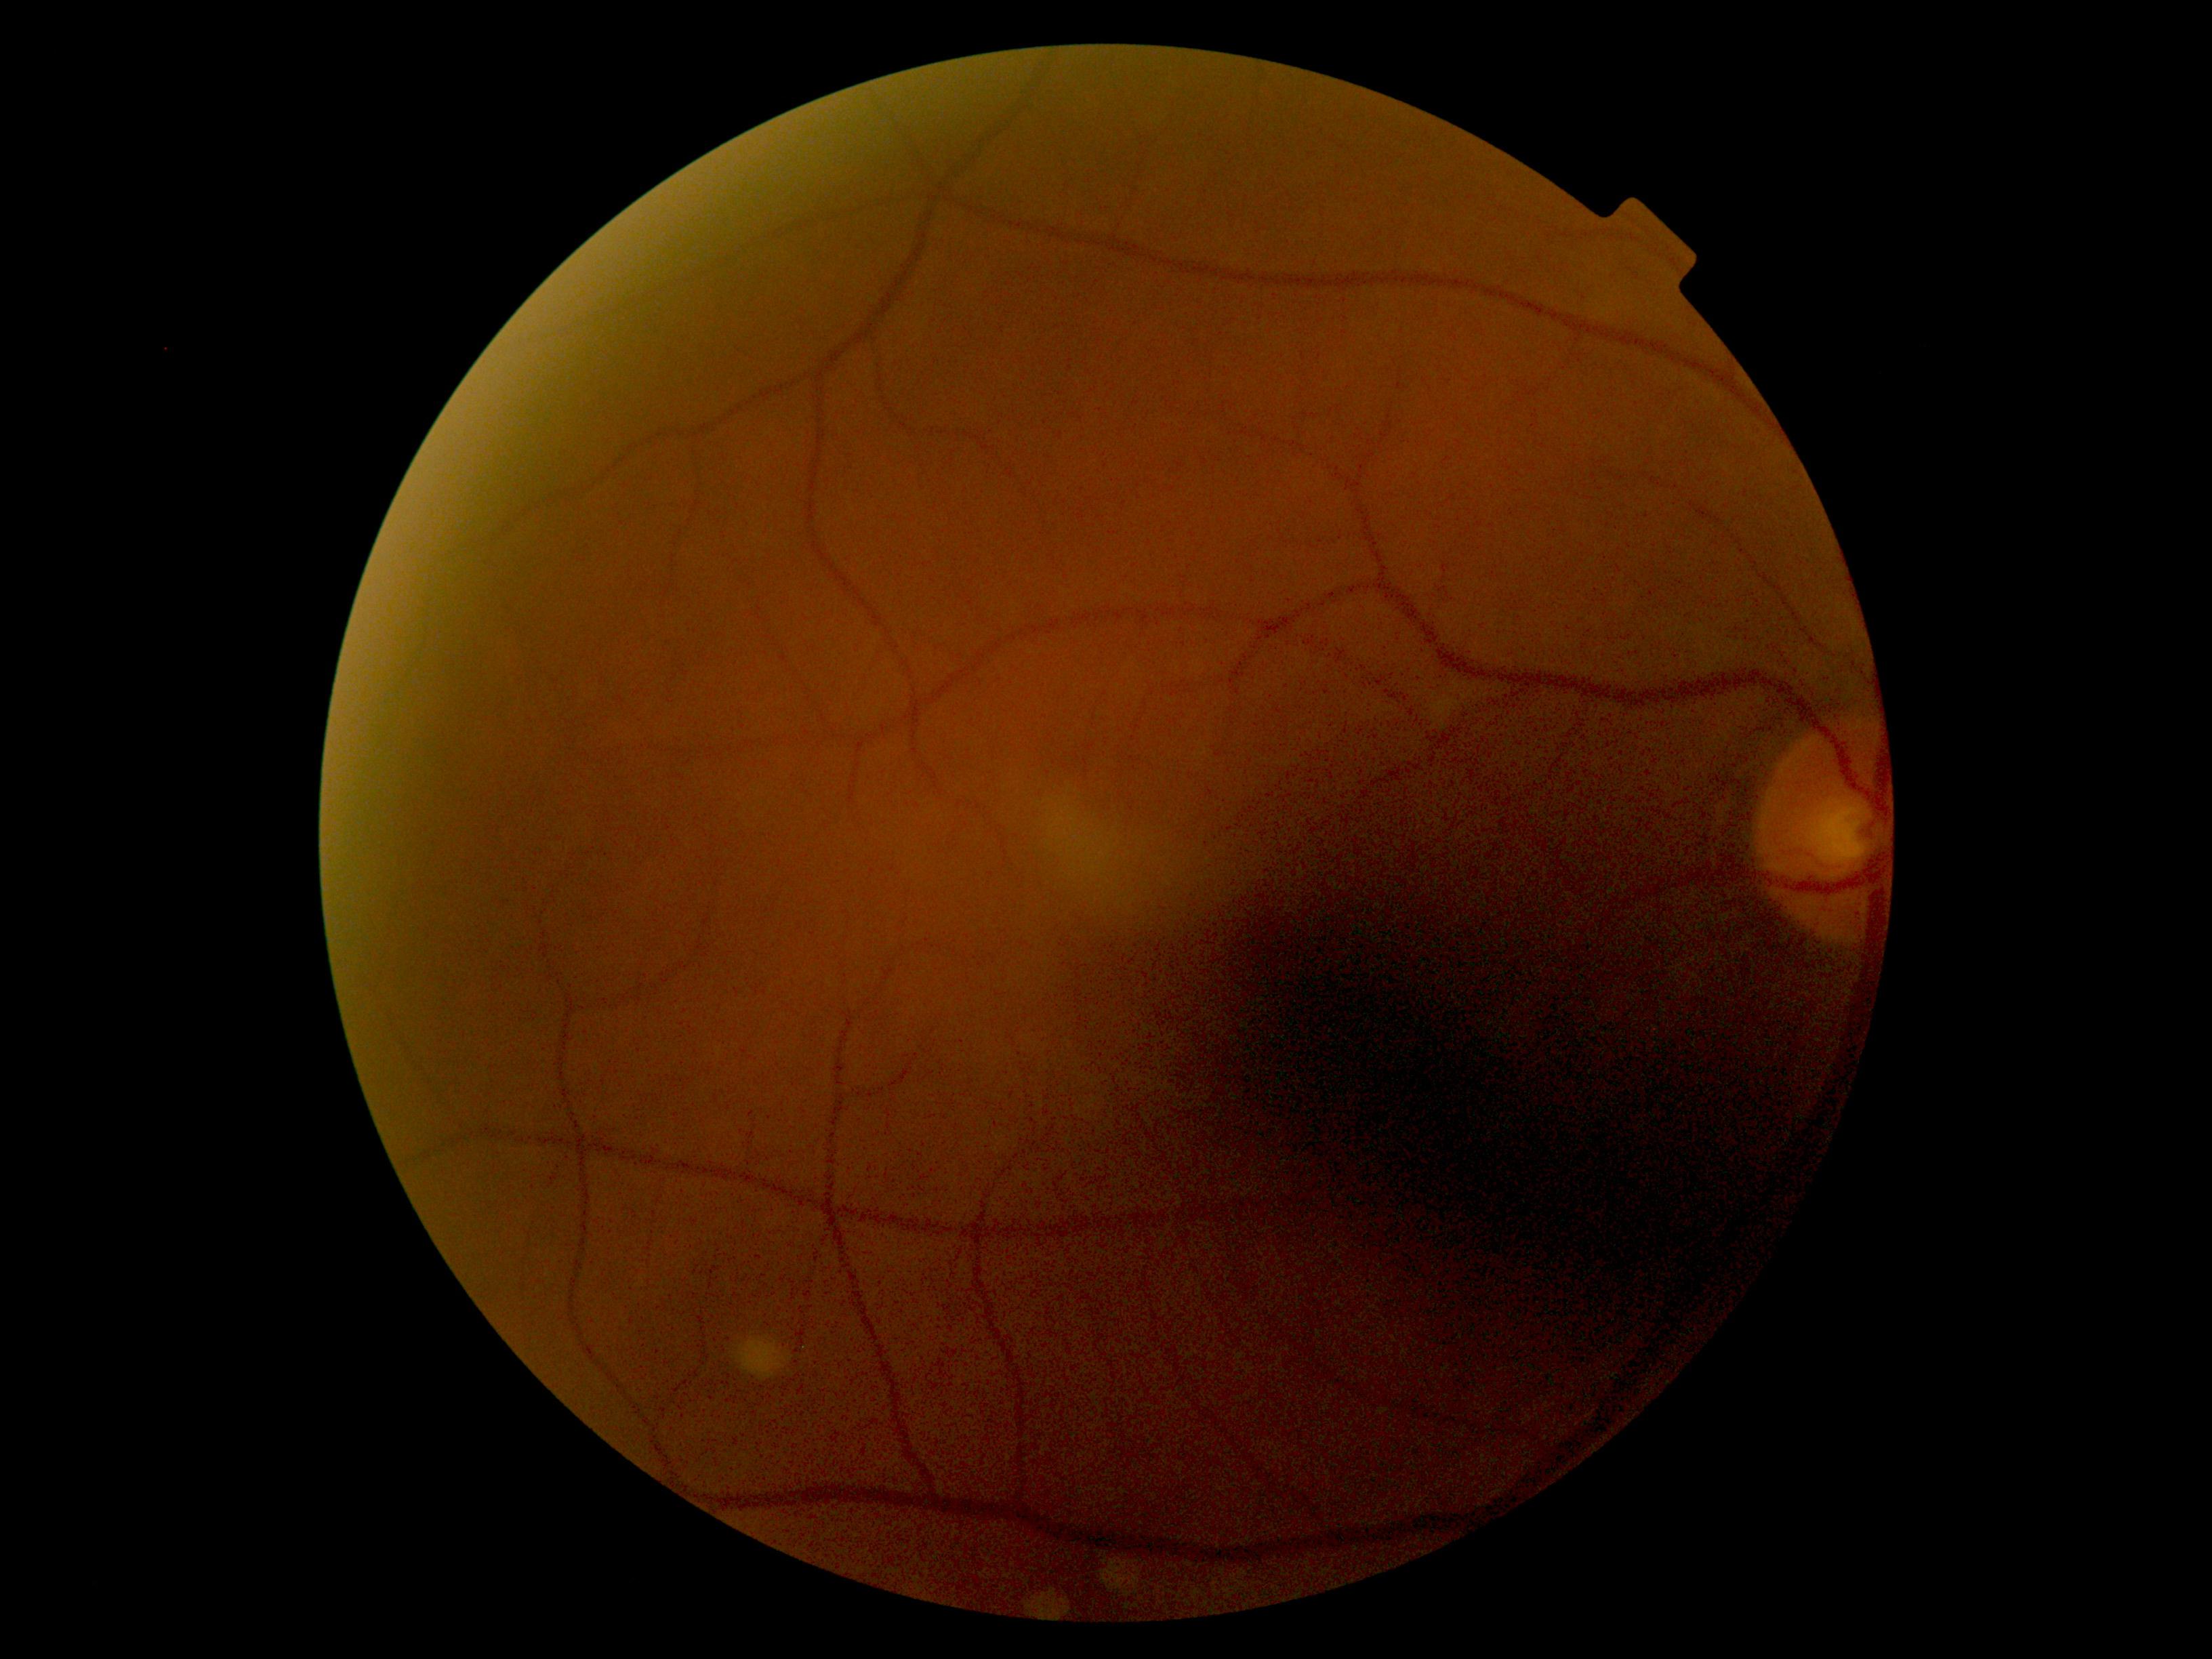

DR grade: 0 — no visible signs of diabetic retinopathy.